NIDEK AFC-230. 848x848. Posterior pole photograph. 45° field of view
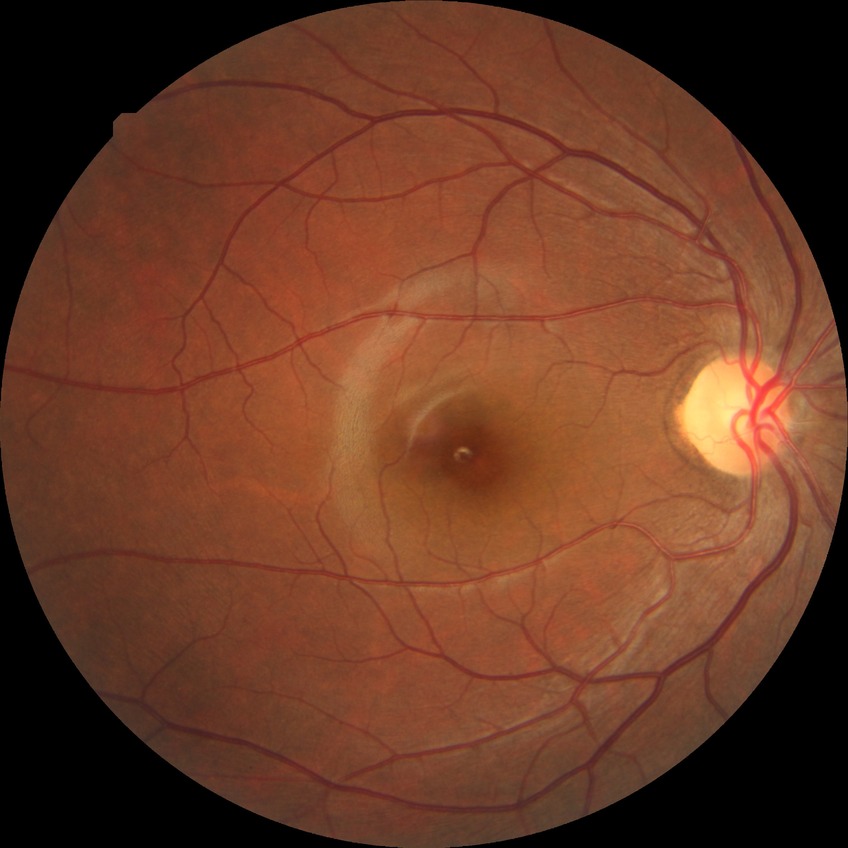

Diabetic retinopathy stage: no diabetic retinopathy.